Davis DR grading; nonmydriatic; NIDEK AFC-230 fundus camera:
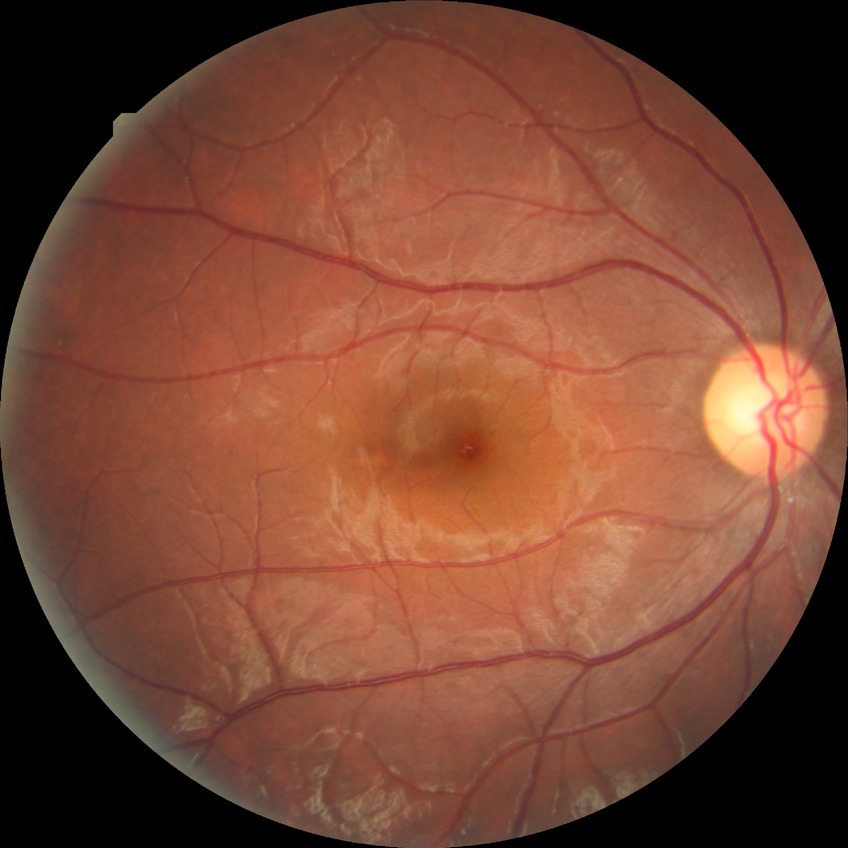 Modified Davis grading: no diabetic retinopathy.